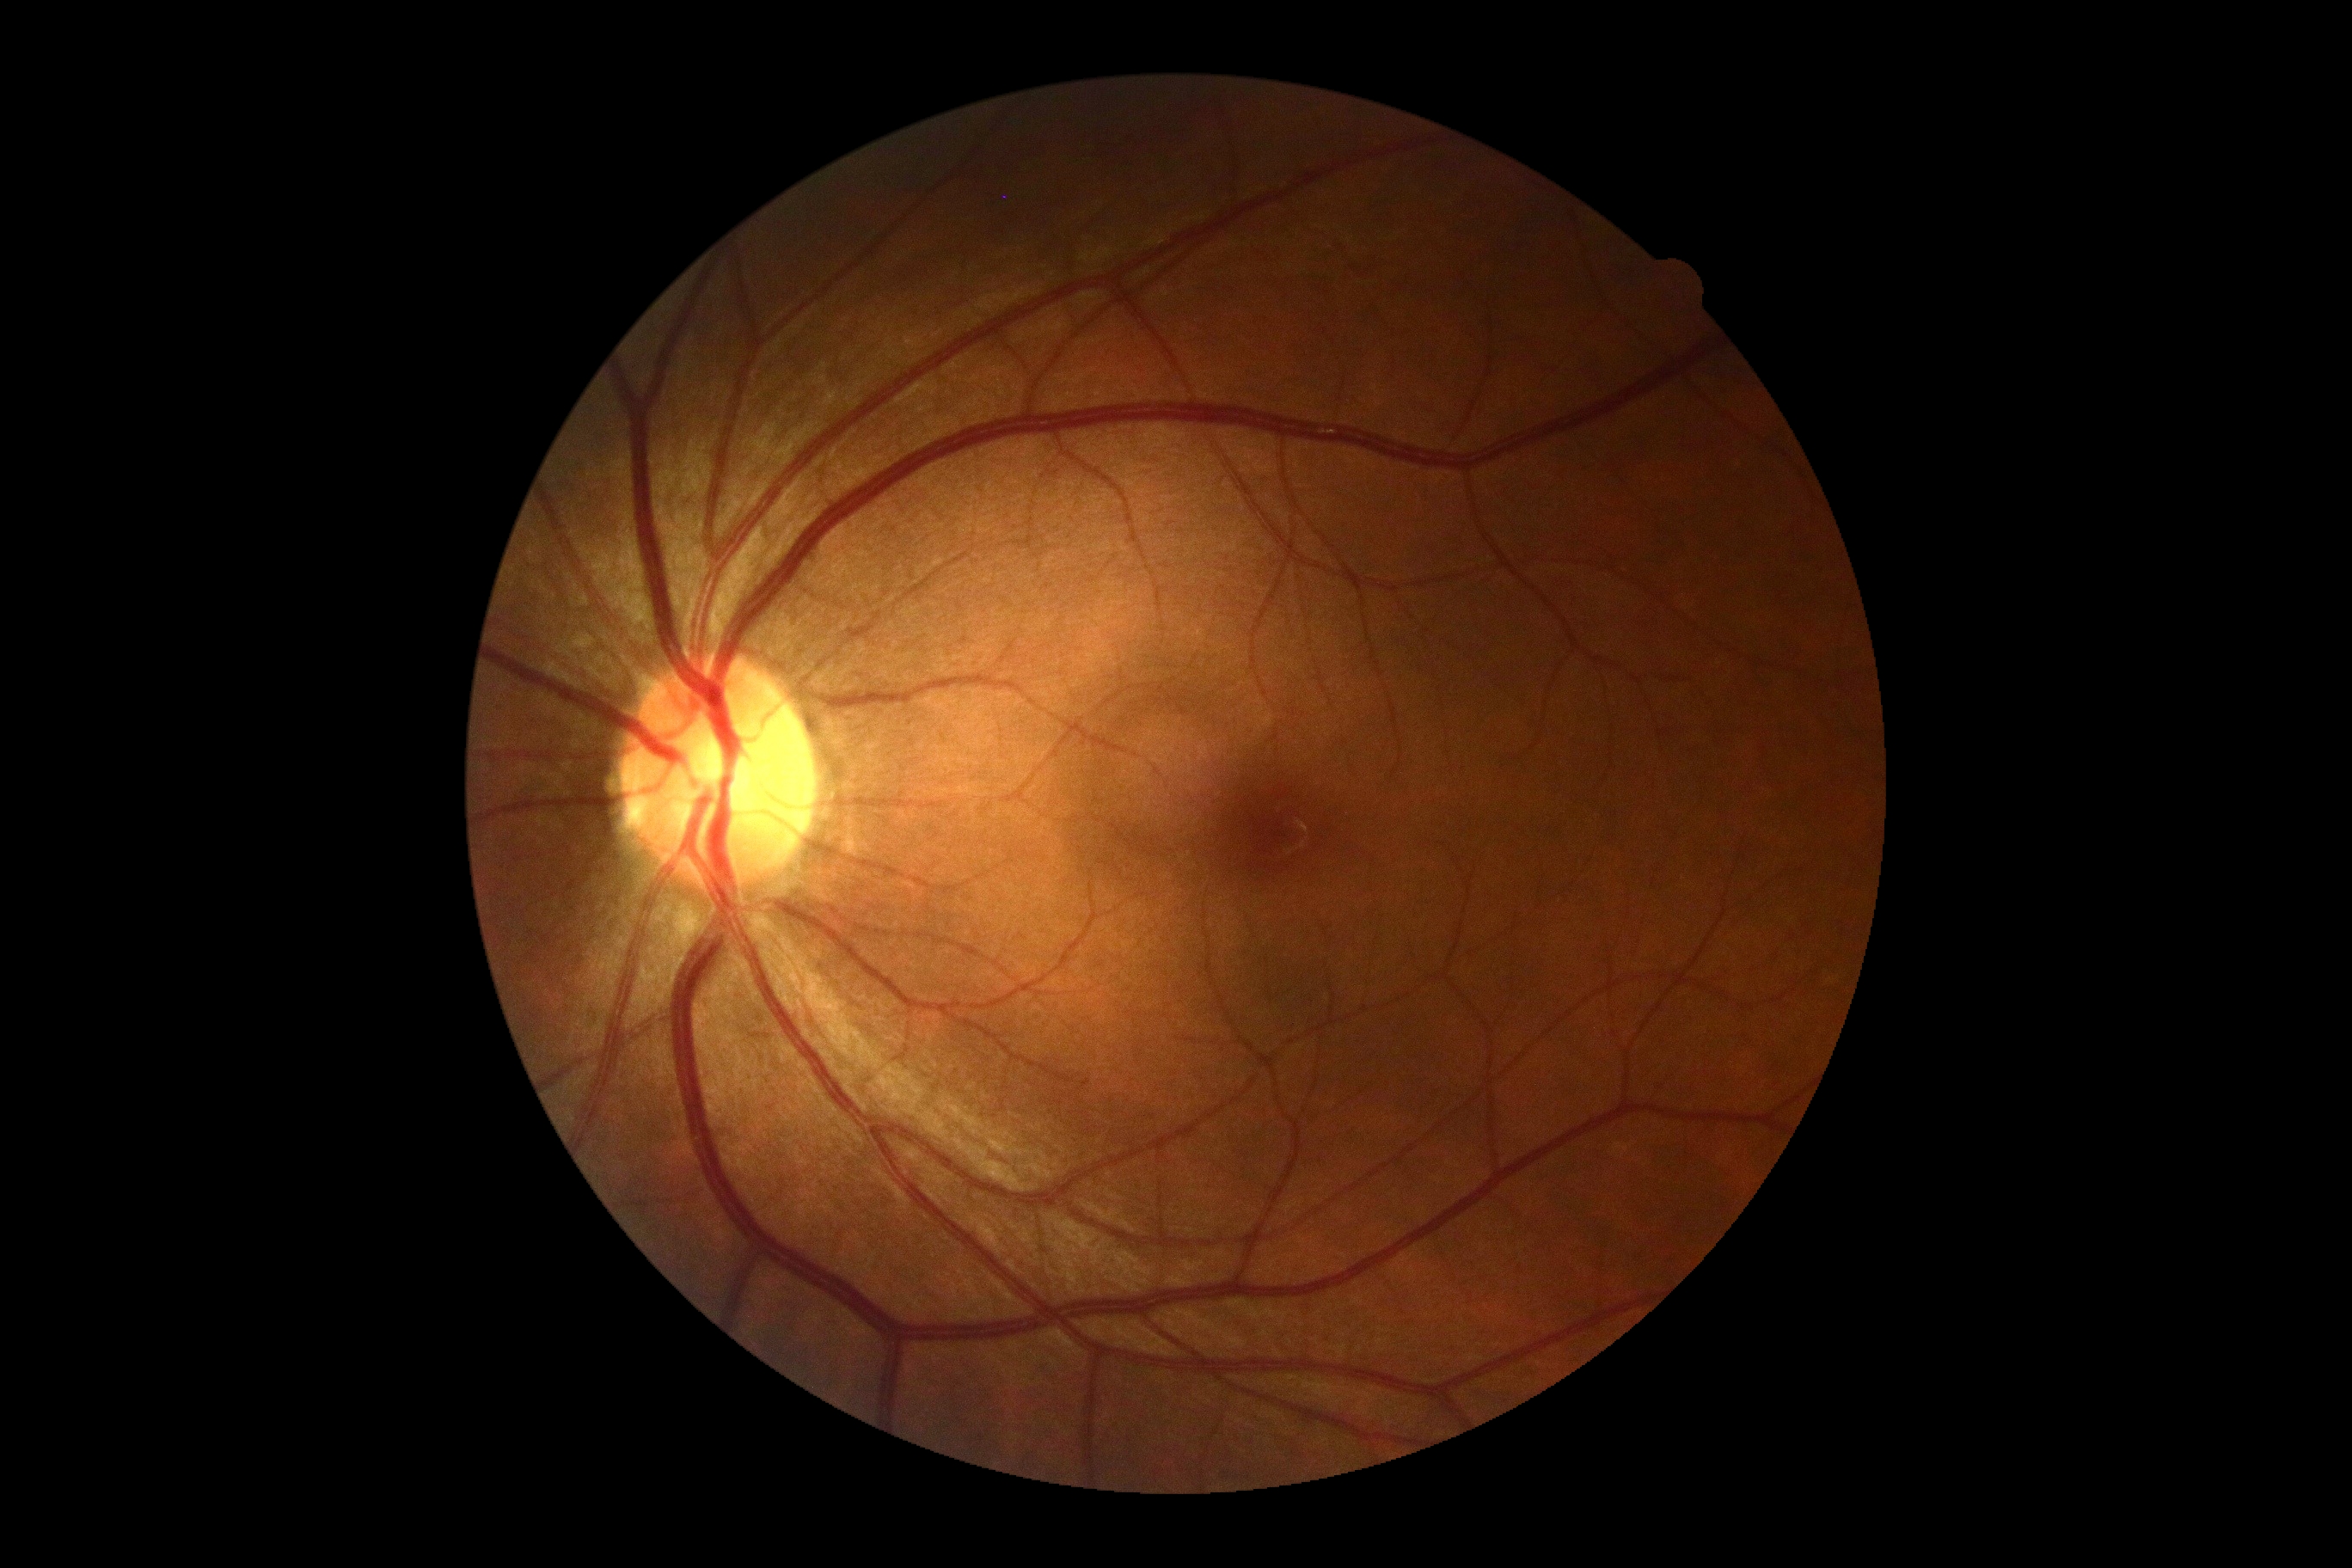

Retinopathy grade is 0 — no visible signs of diabetic retinopathy.